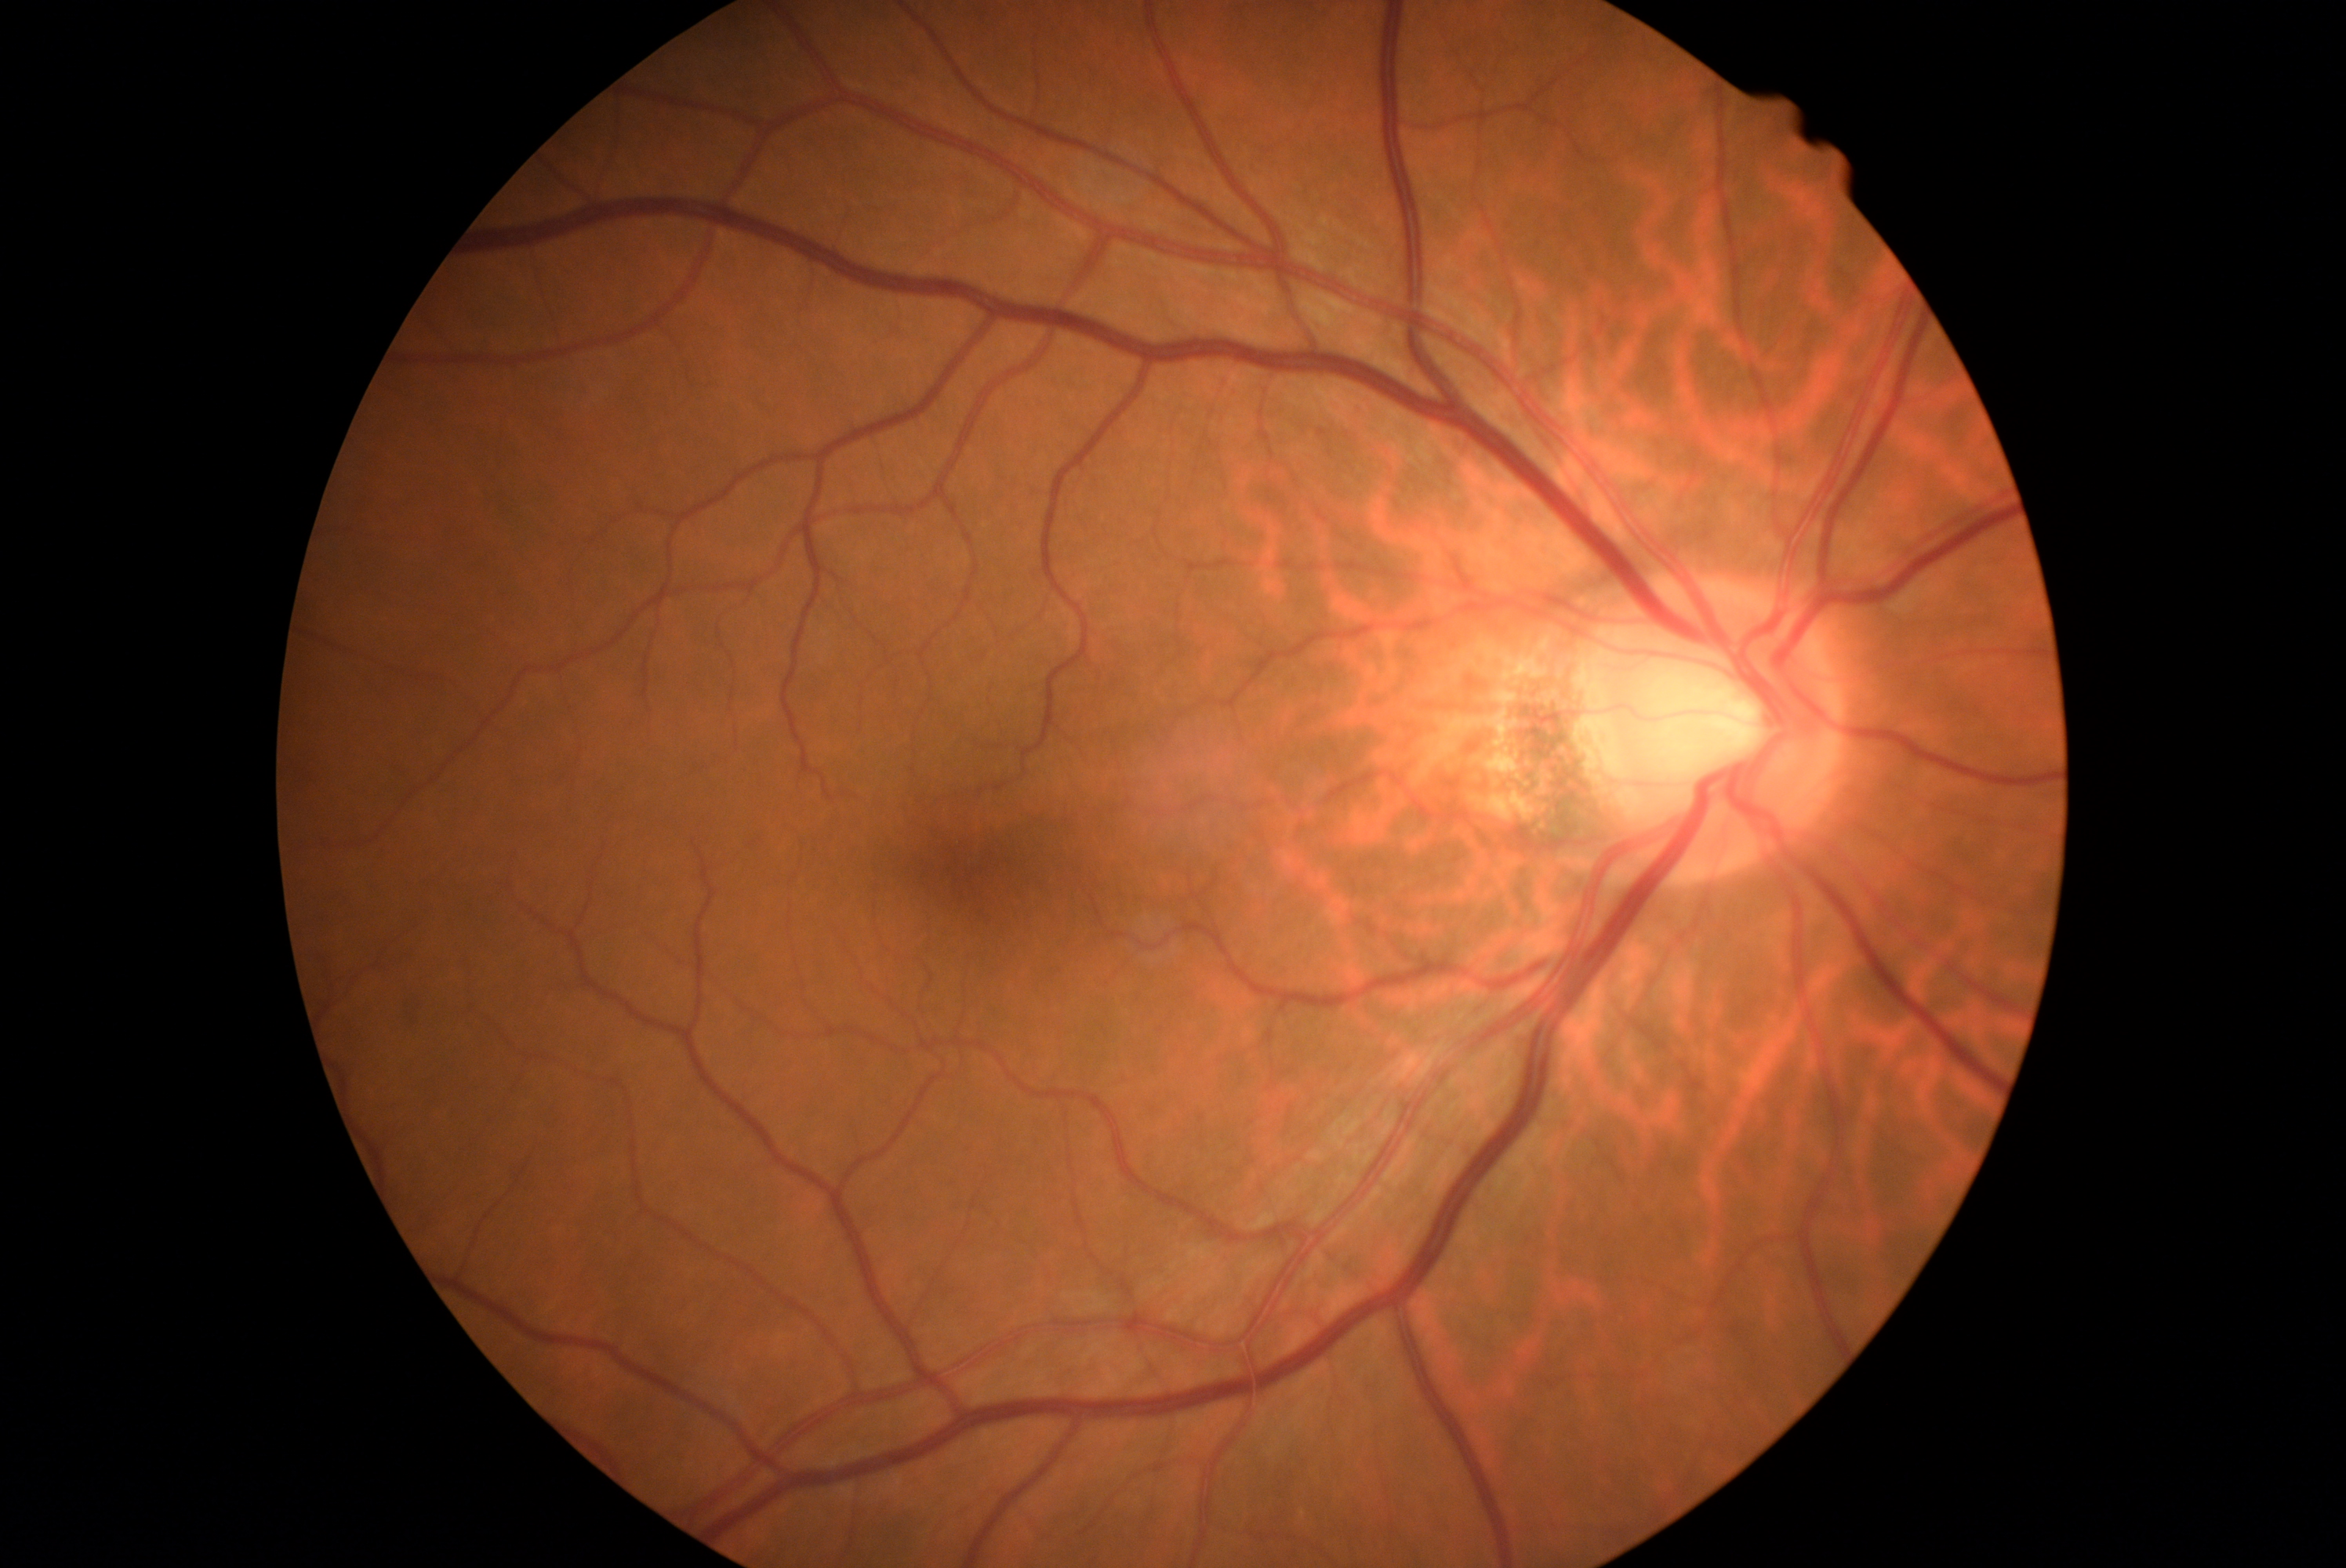

No apparent diabetic retinopathy.
Diabetic retinopathy is 0/4.